640 by 480 pixels; wide-field fundus photograph of an infant; captured with the Clarity RetCam 3 (130° field of view).
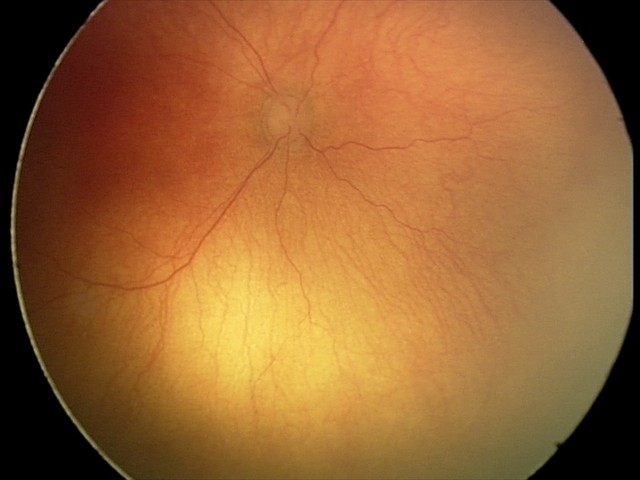

Screening diagnosis: plus disease — abnormal dilation and tortuosity of the posterior pole retinal vessels | aggressive retinopathy of prematurity.